Color fundus photograph — 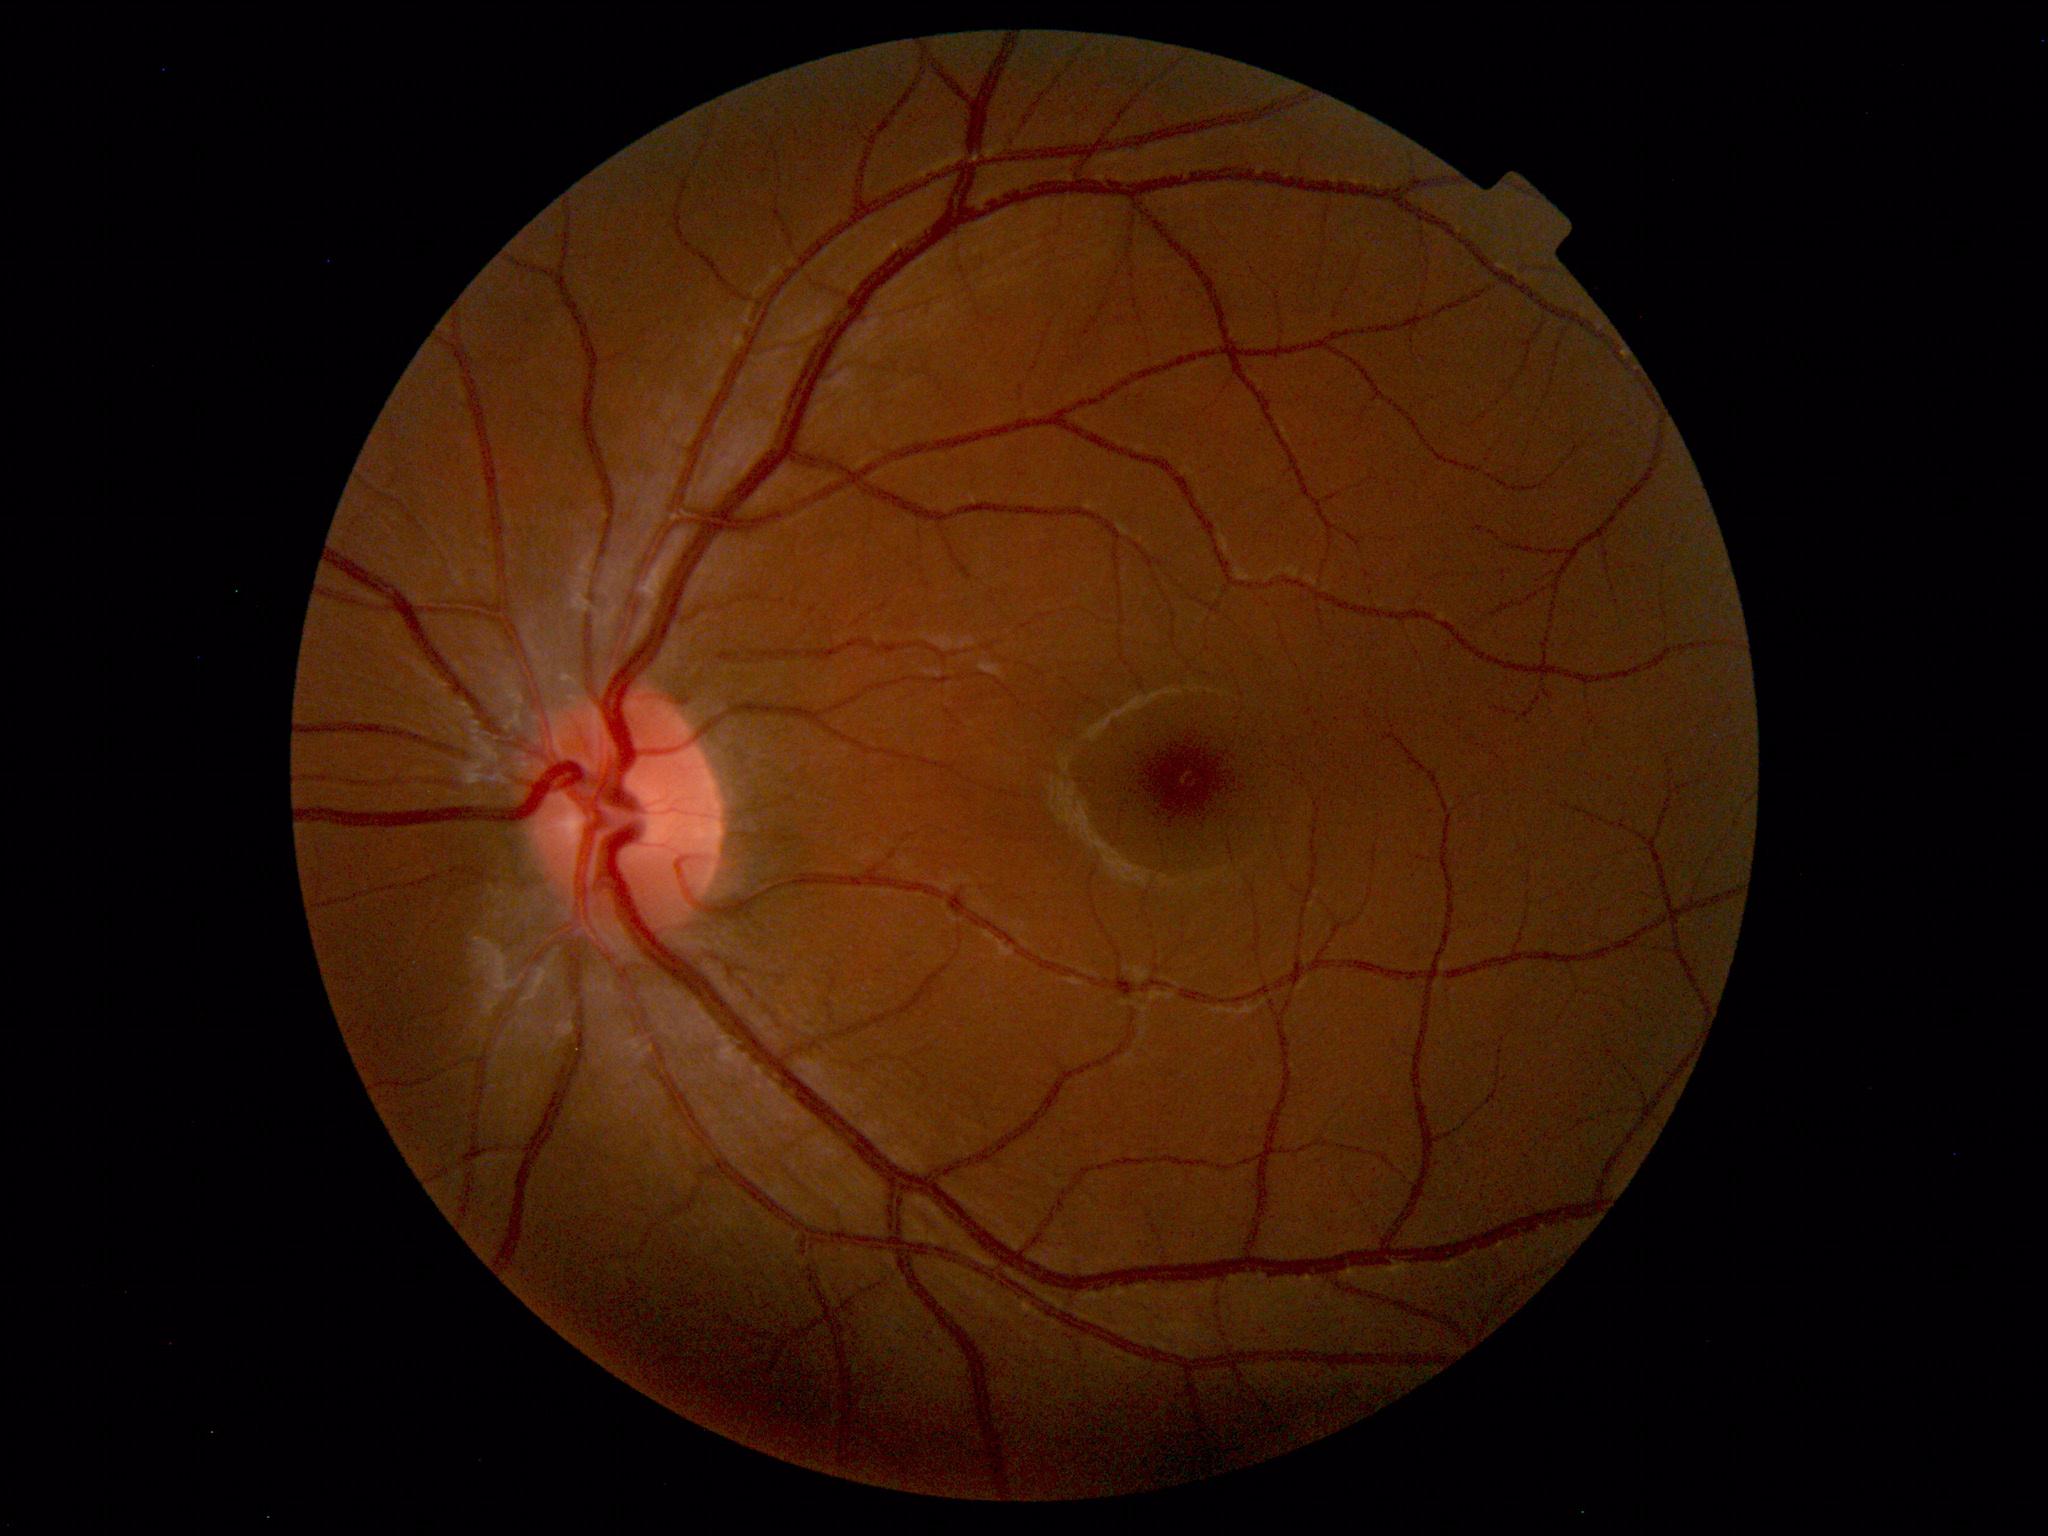

No abnormal findings on fundus examination.